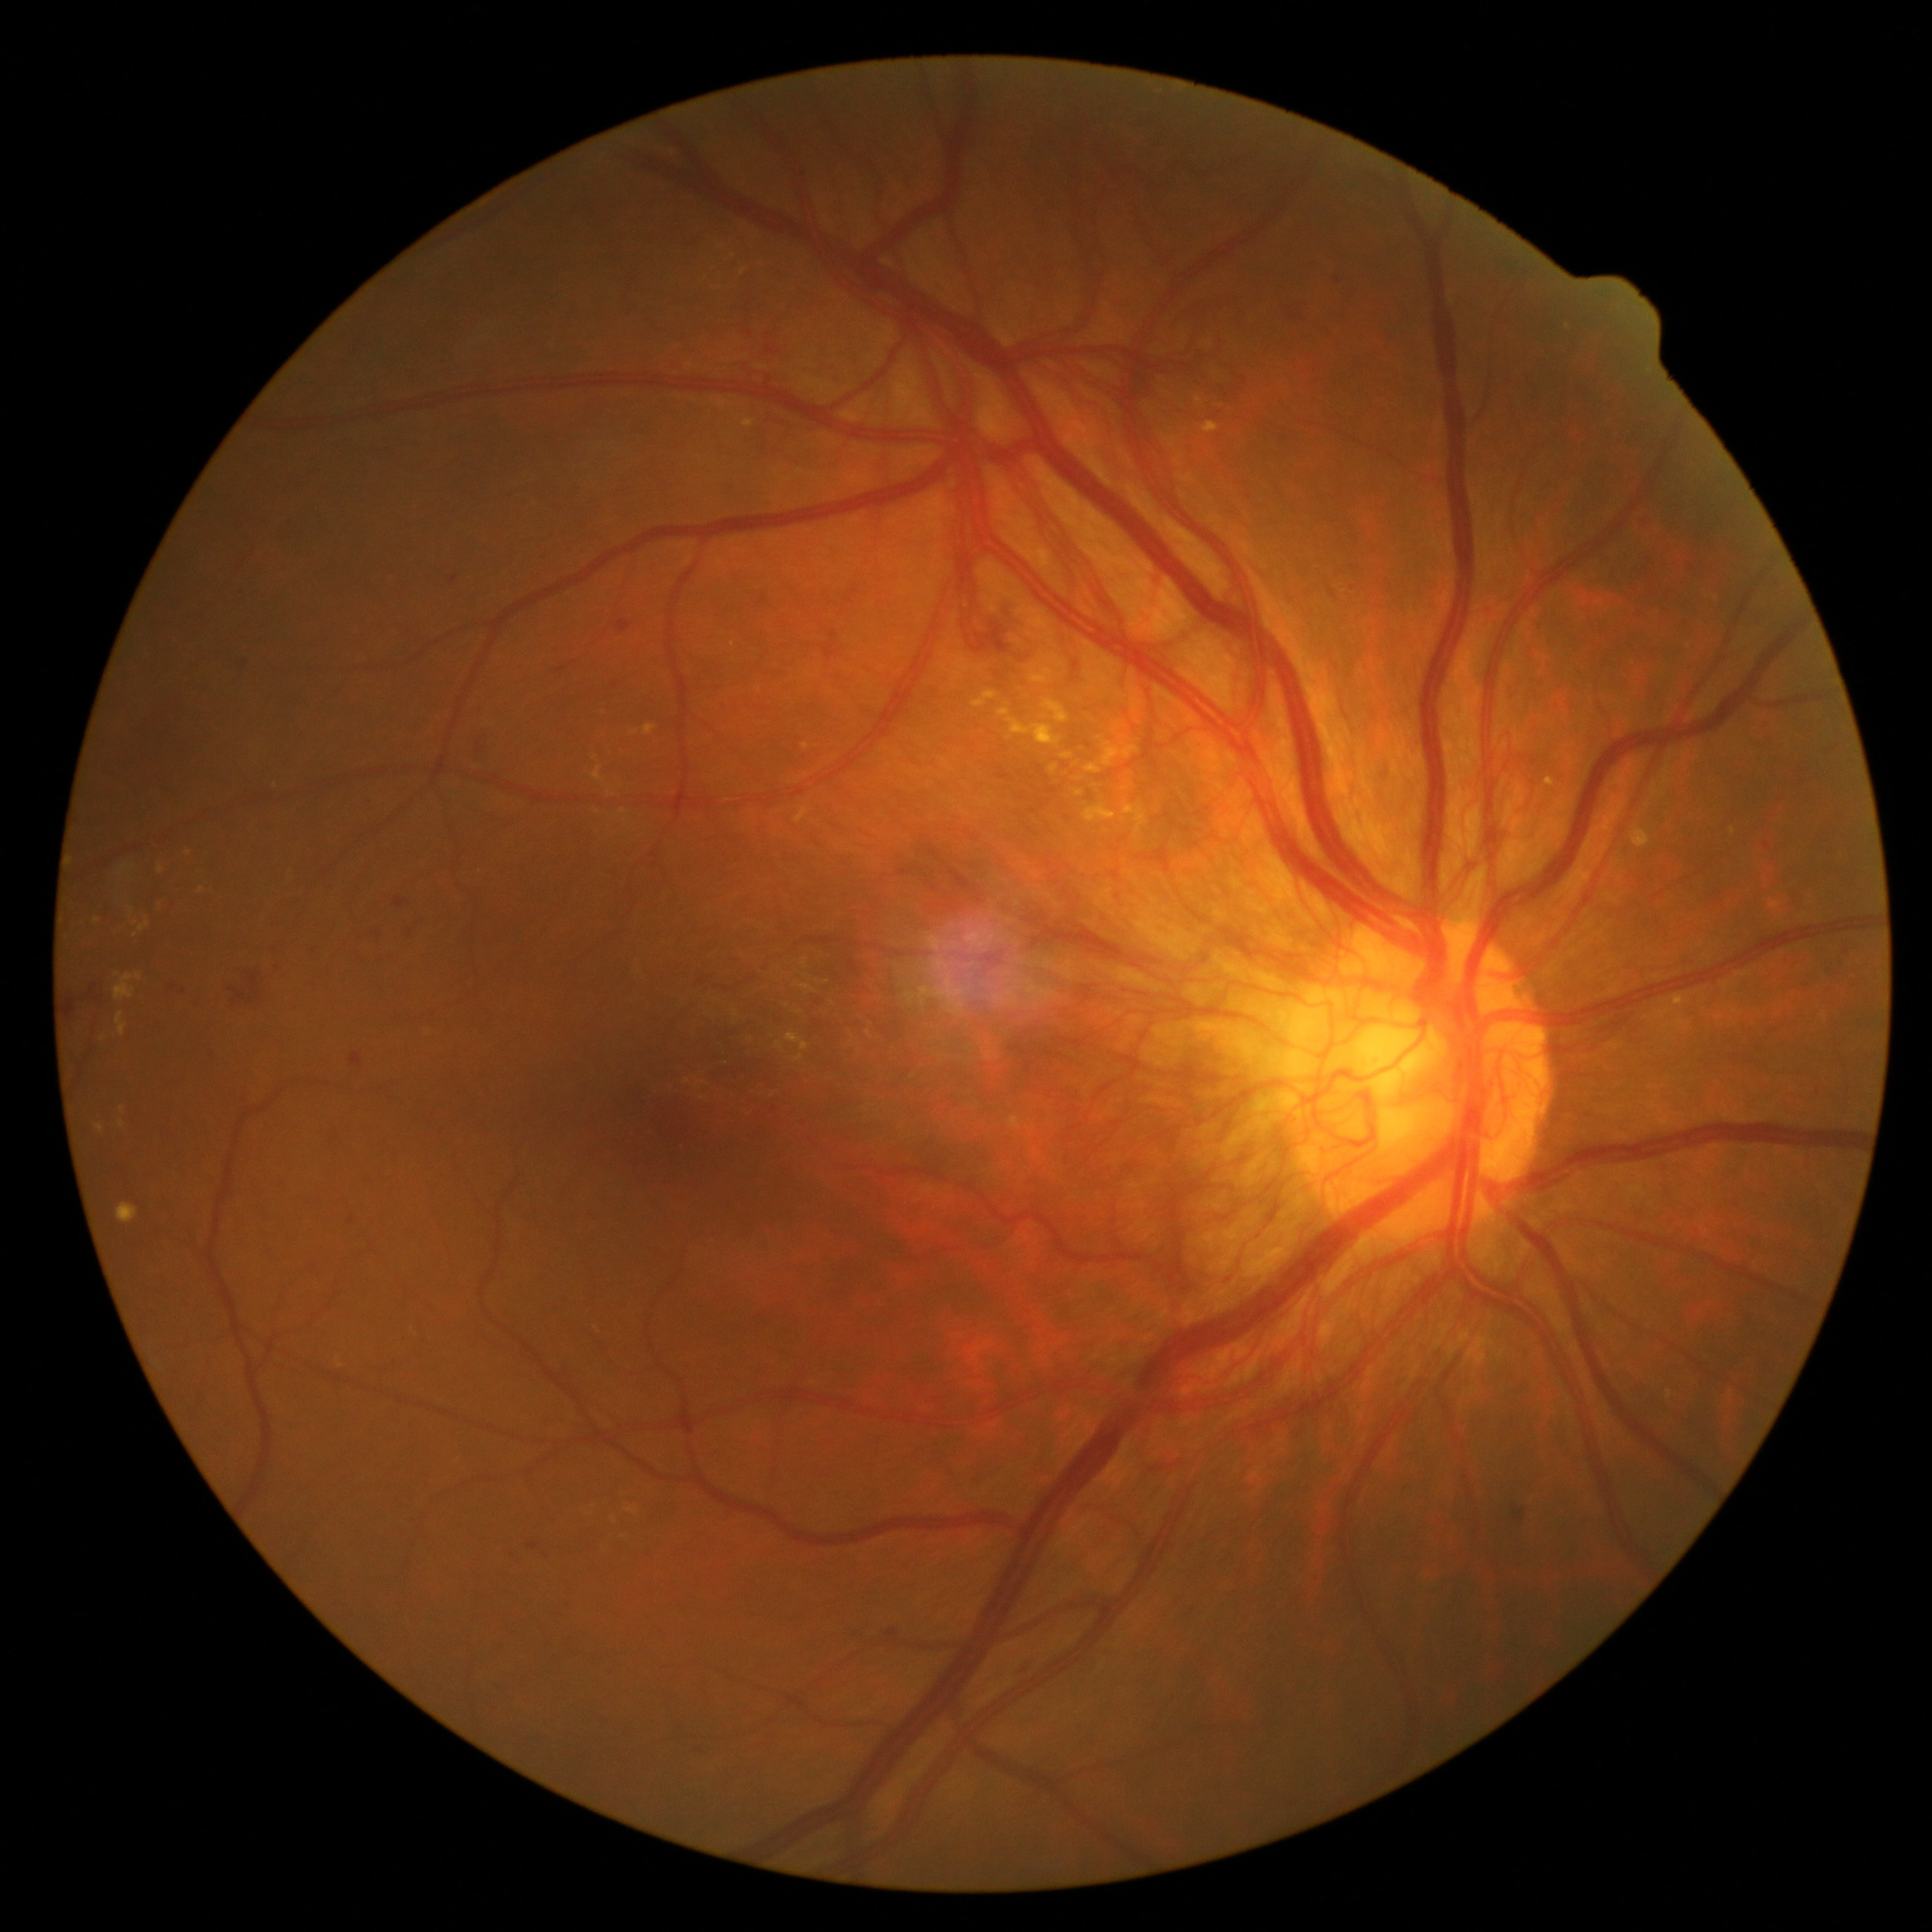

DR severity: grade 4 (PDR)
Lesions identified (partial list):
MAs = none identified
SEs = none identified
HEs (subset) = (374, 930, 382, 937); (972, 600, 1052, 662); (63, 995, 78, 1021); (349, 1053, 363, 1068); (450, 576, 459, 583); (473, 728, 491, 763); (1513, 1507, 1524, 1521); (527, 1542, 539, 1550); (1688, 564, 1696, 571); (169, 983, 176, 991); (362, 797, 376, 808)
Additional small HEs near (1646; 523); (1337; 280); (278; 967); (212; 1055)
EXs (subset) = (139, 920, 149, 932); (1040, 698, 1069, 724); (1201, 422, 1220, 432); (631, 731, 640, 736); (1055, 659, 1064, 668); (117, 1202, 139, 1223); (996, 707, 1064, 747); (116, 1012, 128, 1036); (1060, 752, 1073, 760)
Additional small EXs near (103; 1039); (188; 853); (623; 813); (1052; 659); (122; 1124)